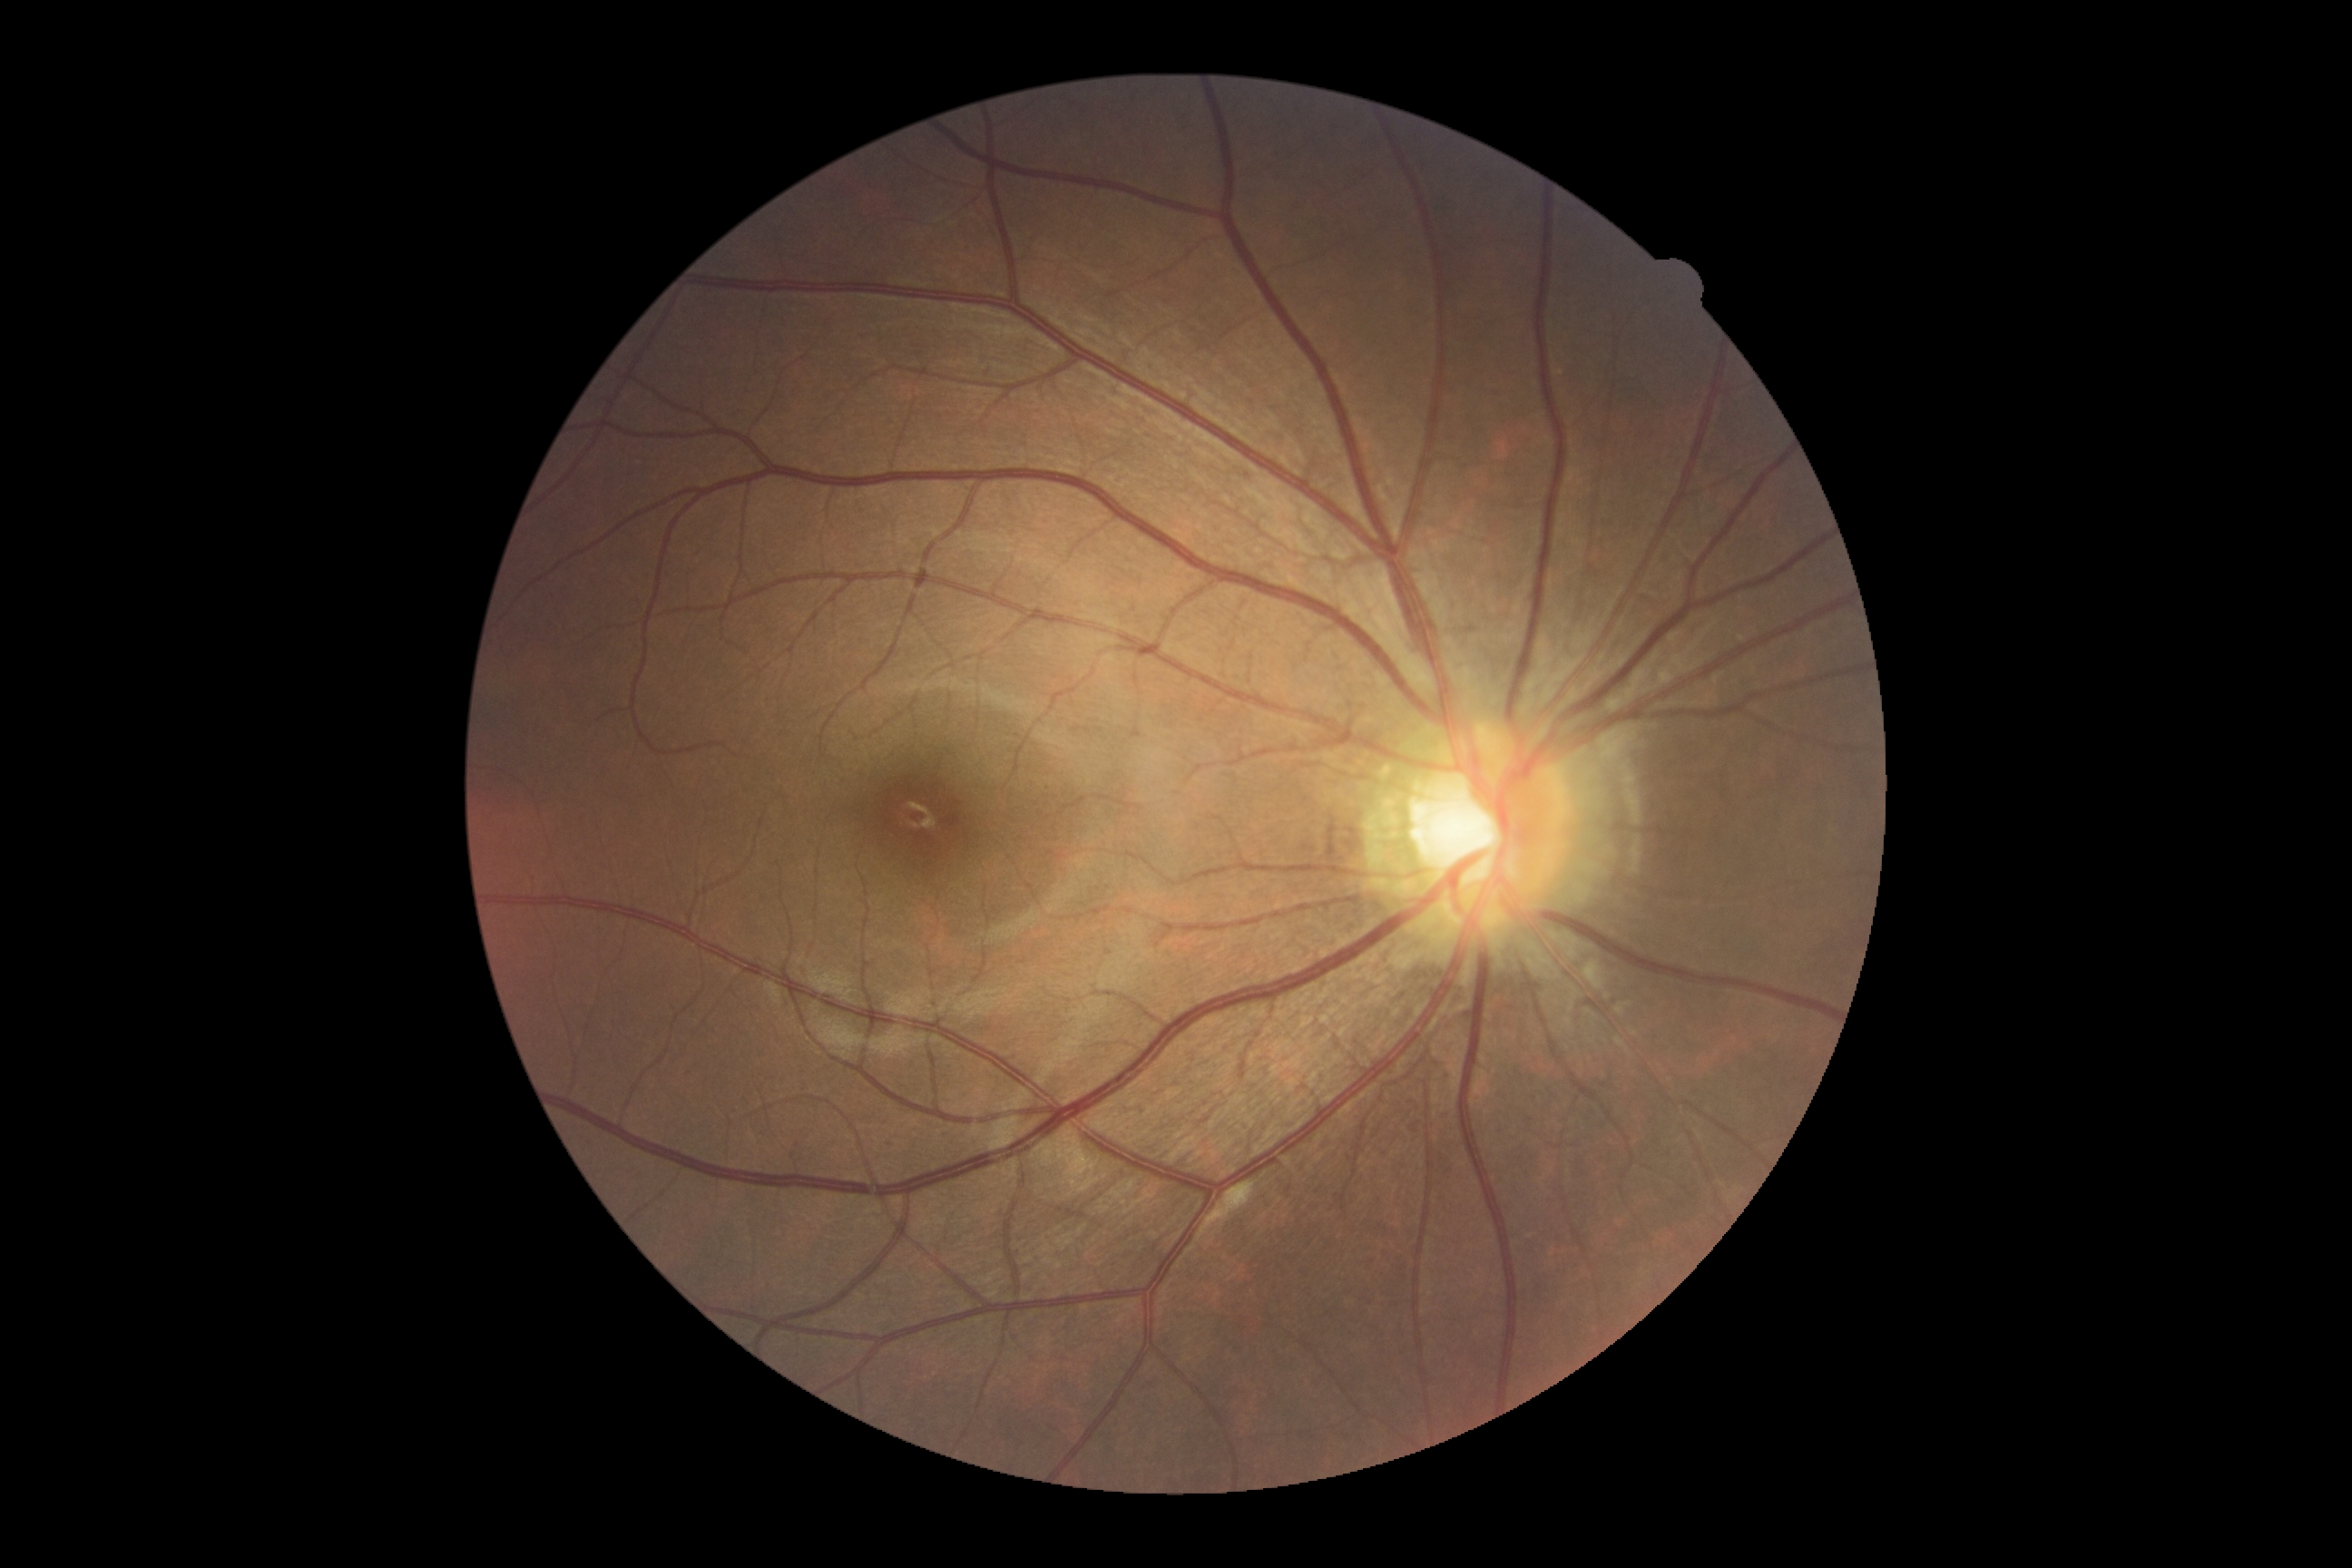
DR grade: 0.